45° FOV:
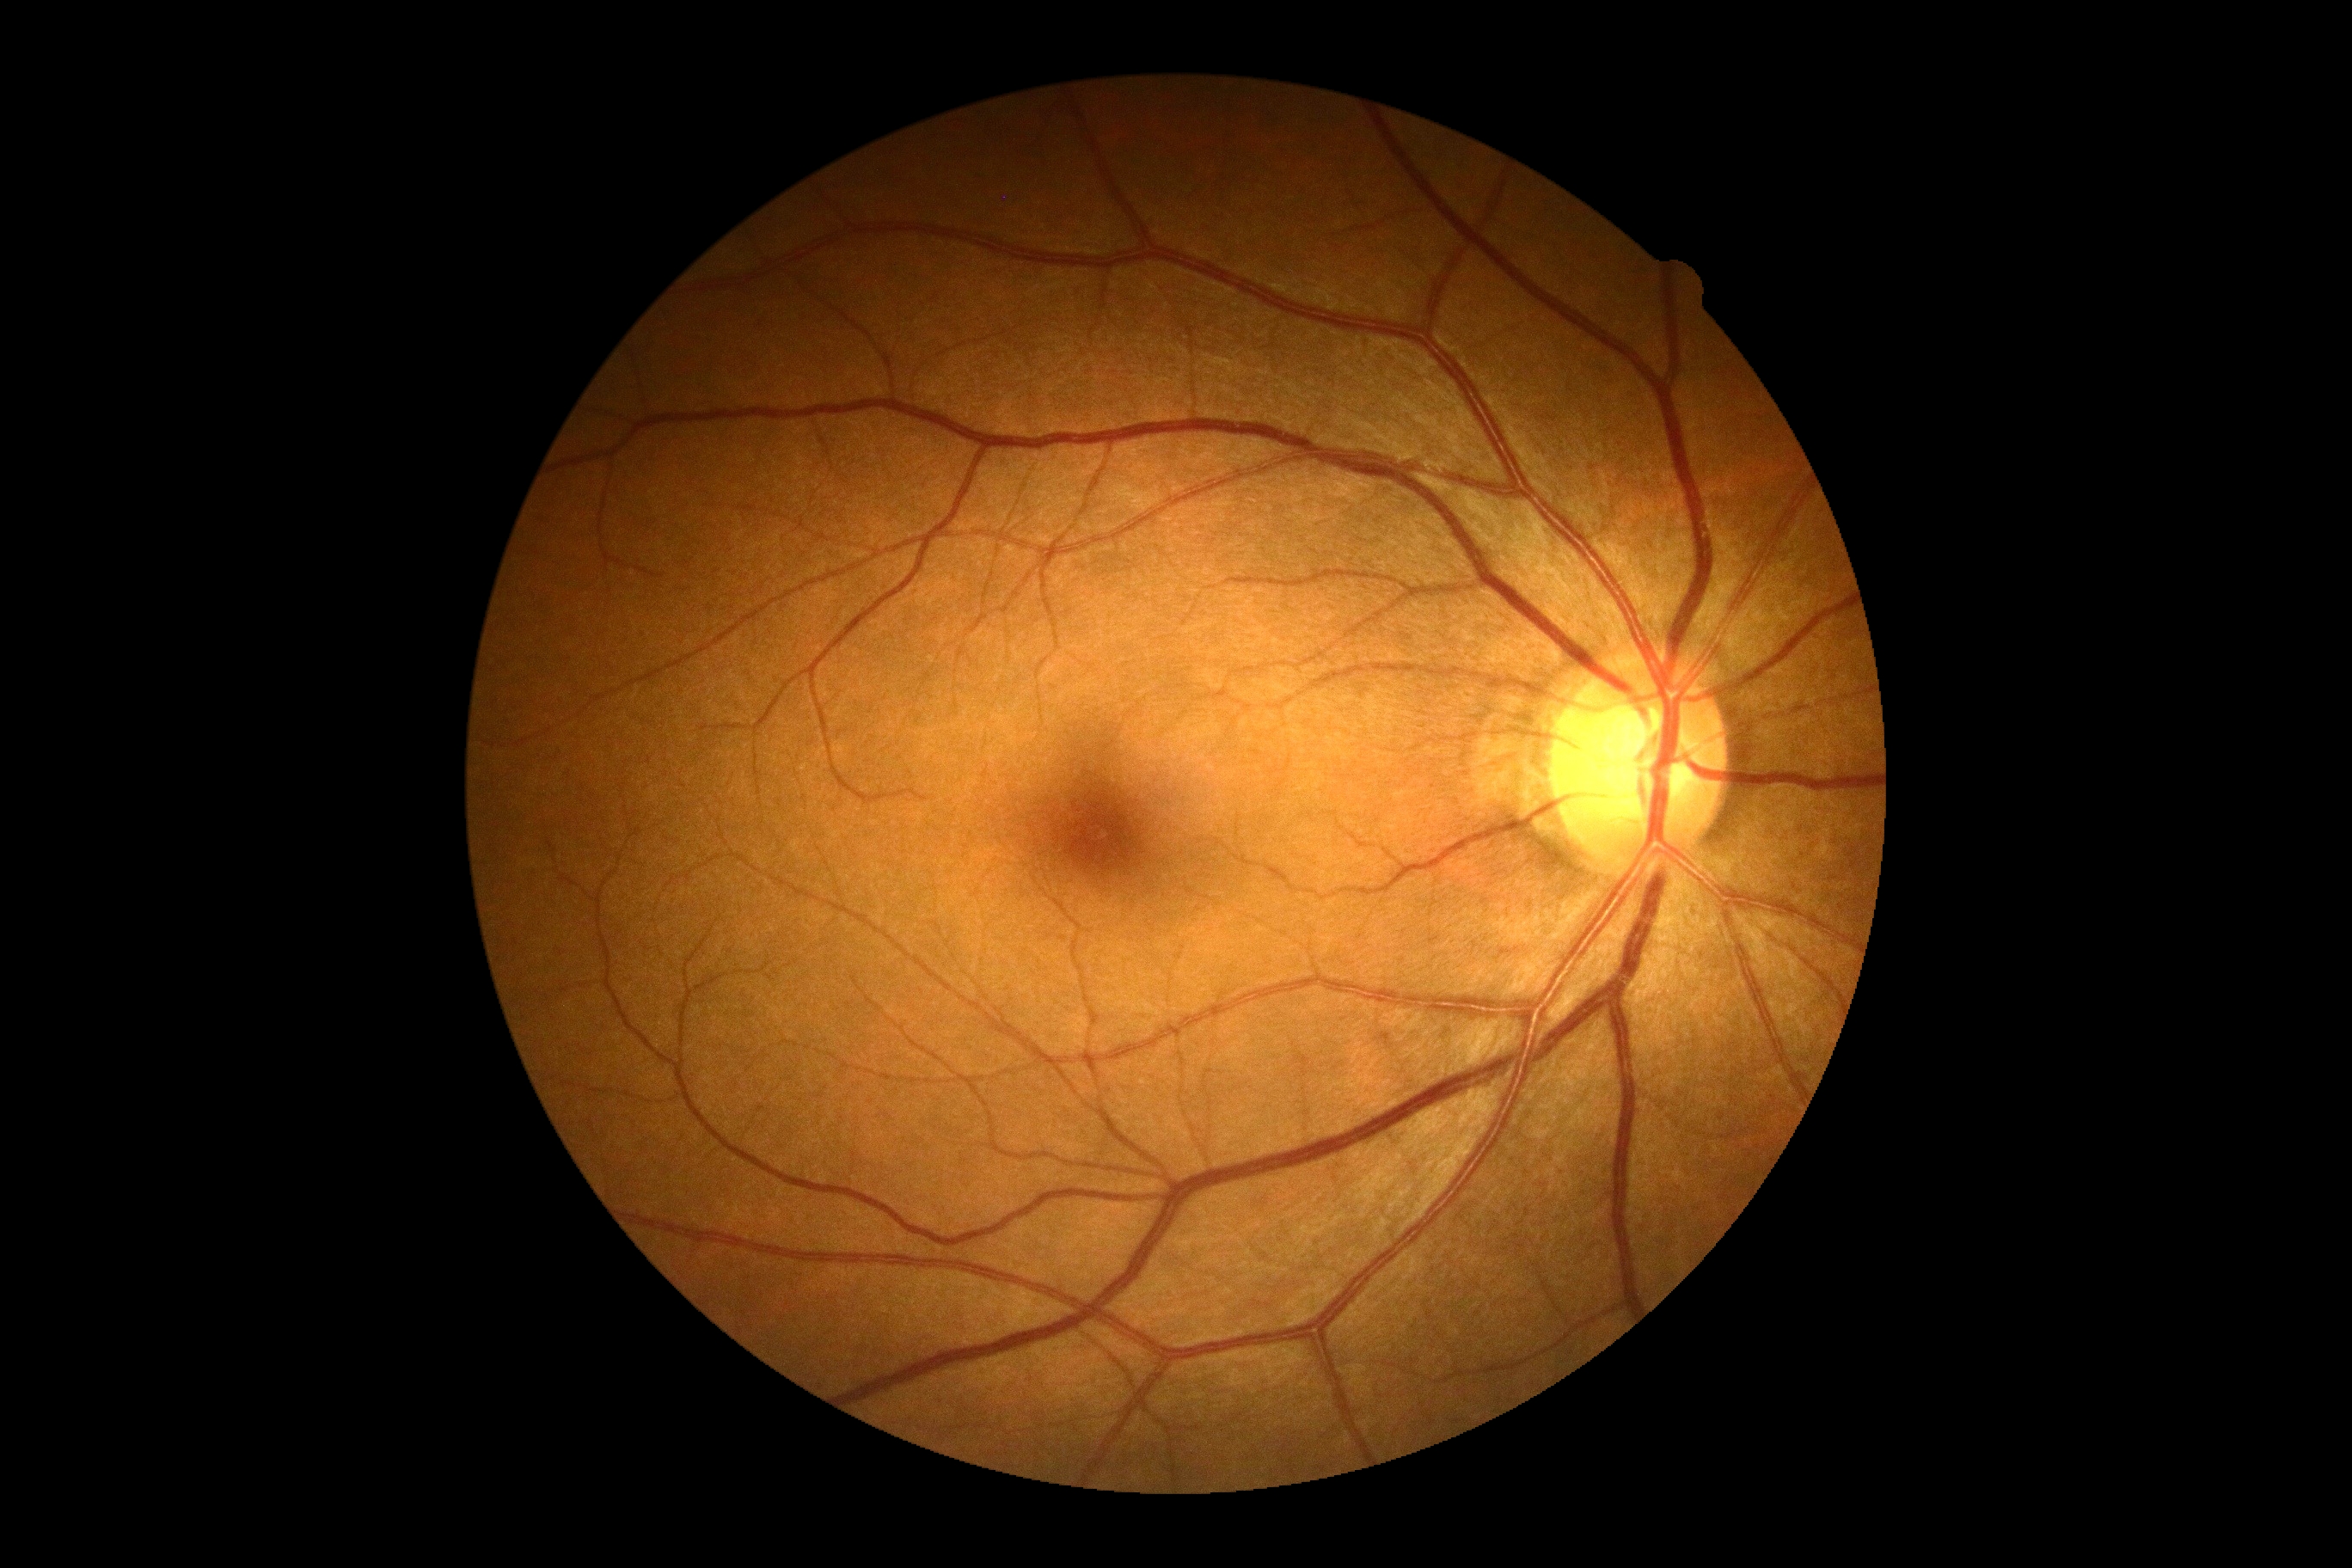

Diabetic retinopathy (DR): grade 0 (no apparent retinopathy). No DR findings.